Camera: Topcon TRC-NW400; 2212x1661; 30-degree field of view; color fundus photograph
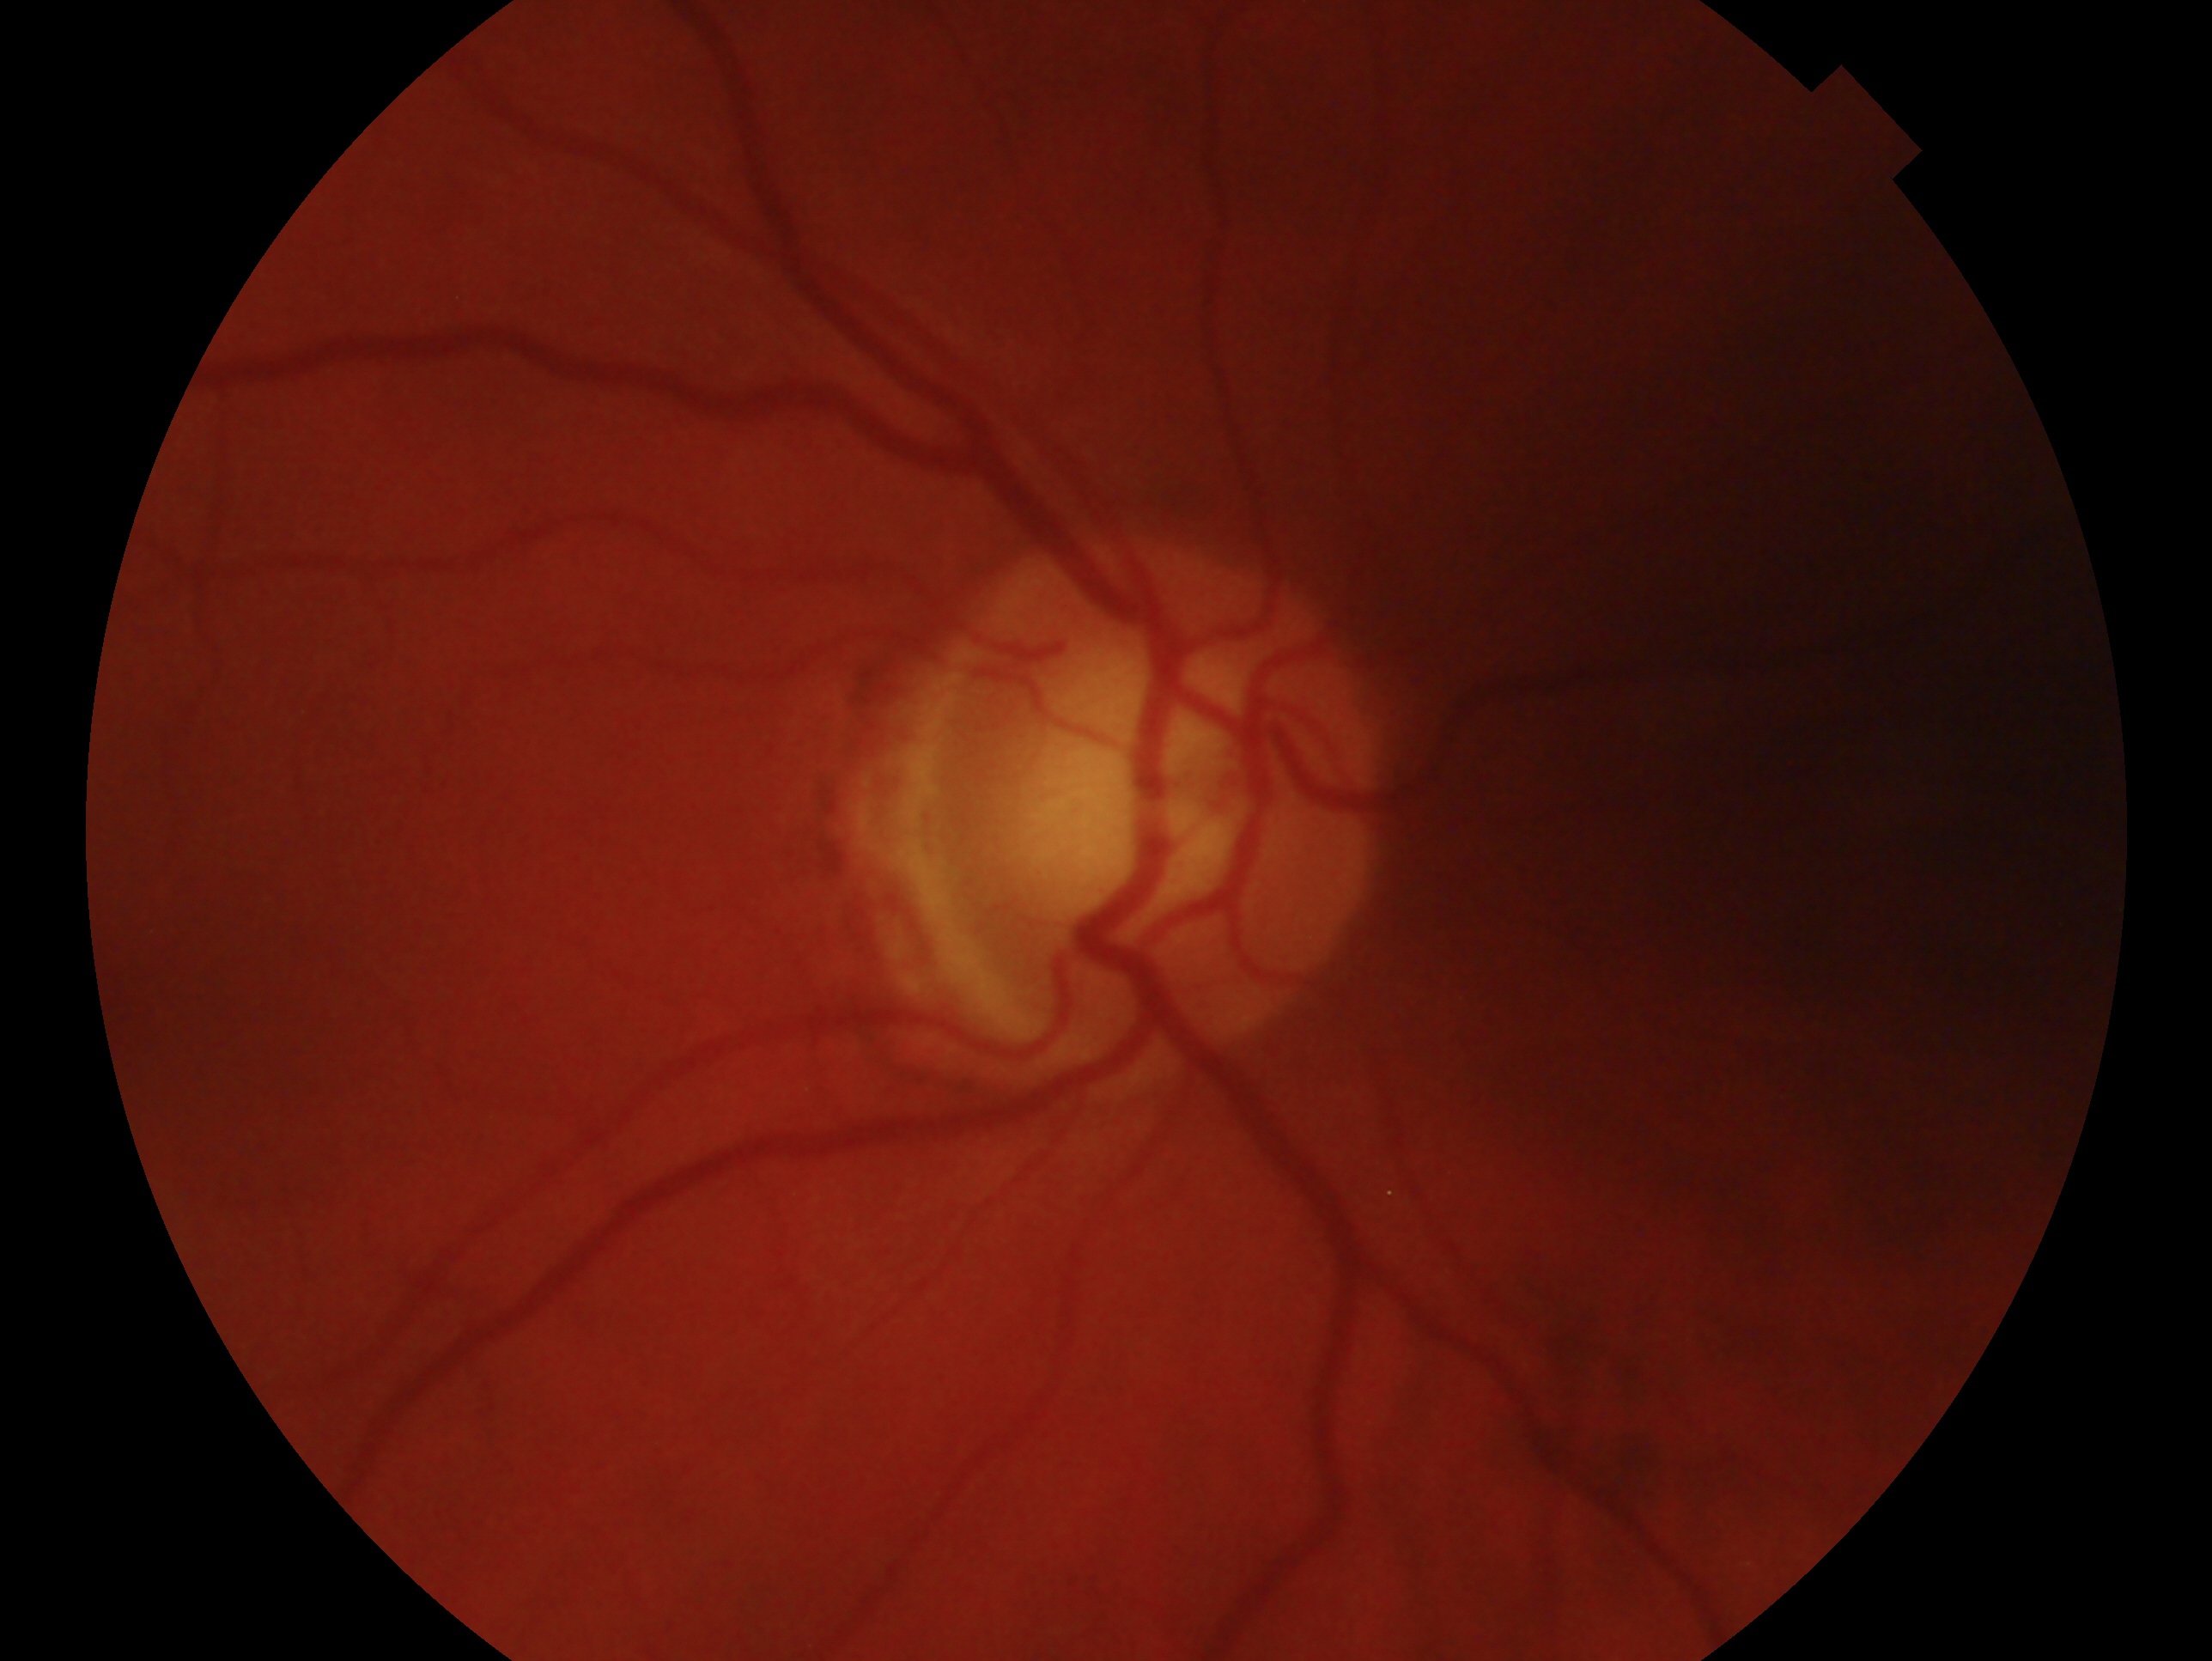

Annotations:
– laterality: oculus dexter
– impression: glaucoma cannot be excluded